45° FOV. Fundus photo. 2048 by 1536 pixels.
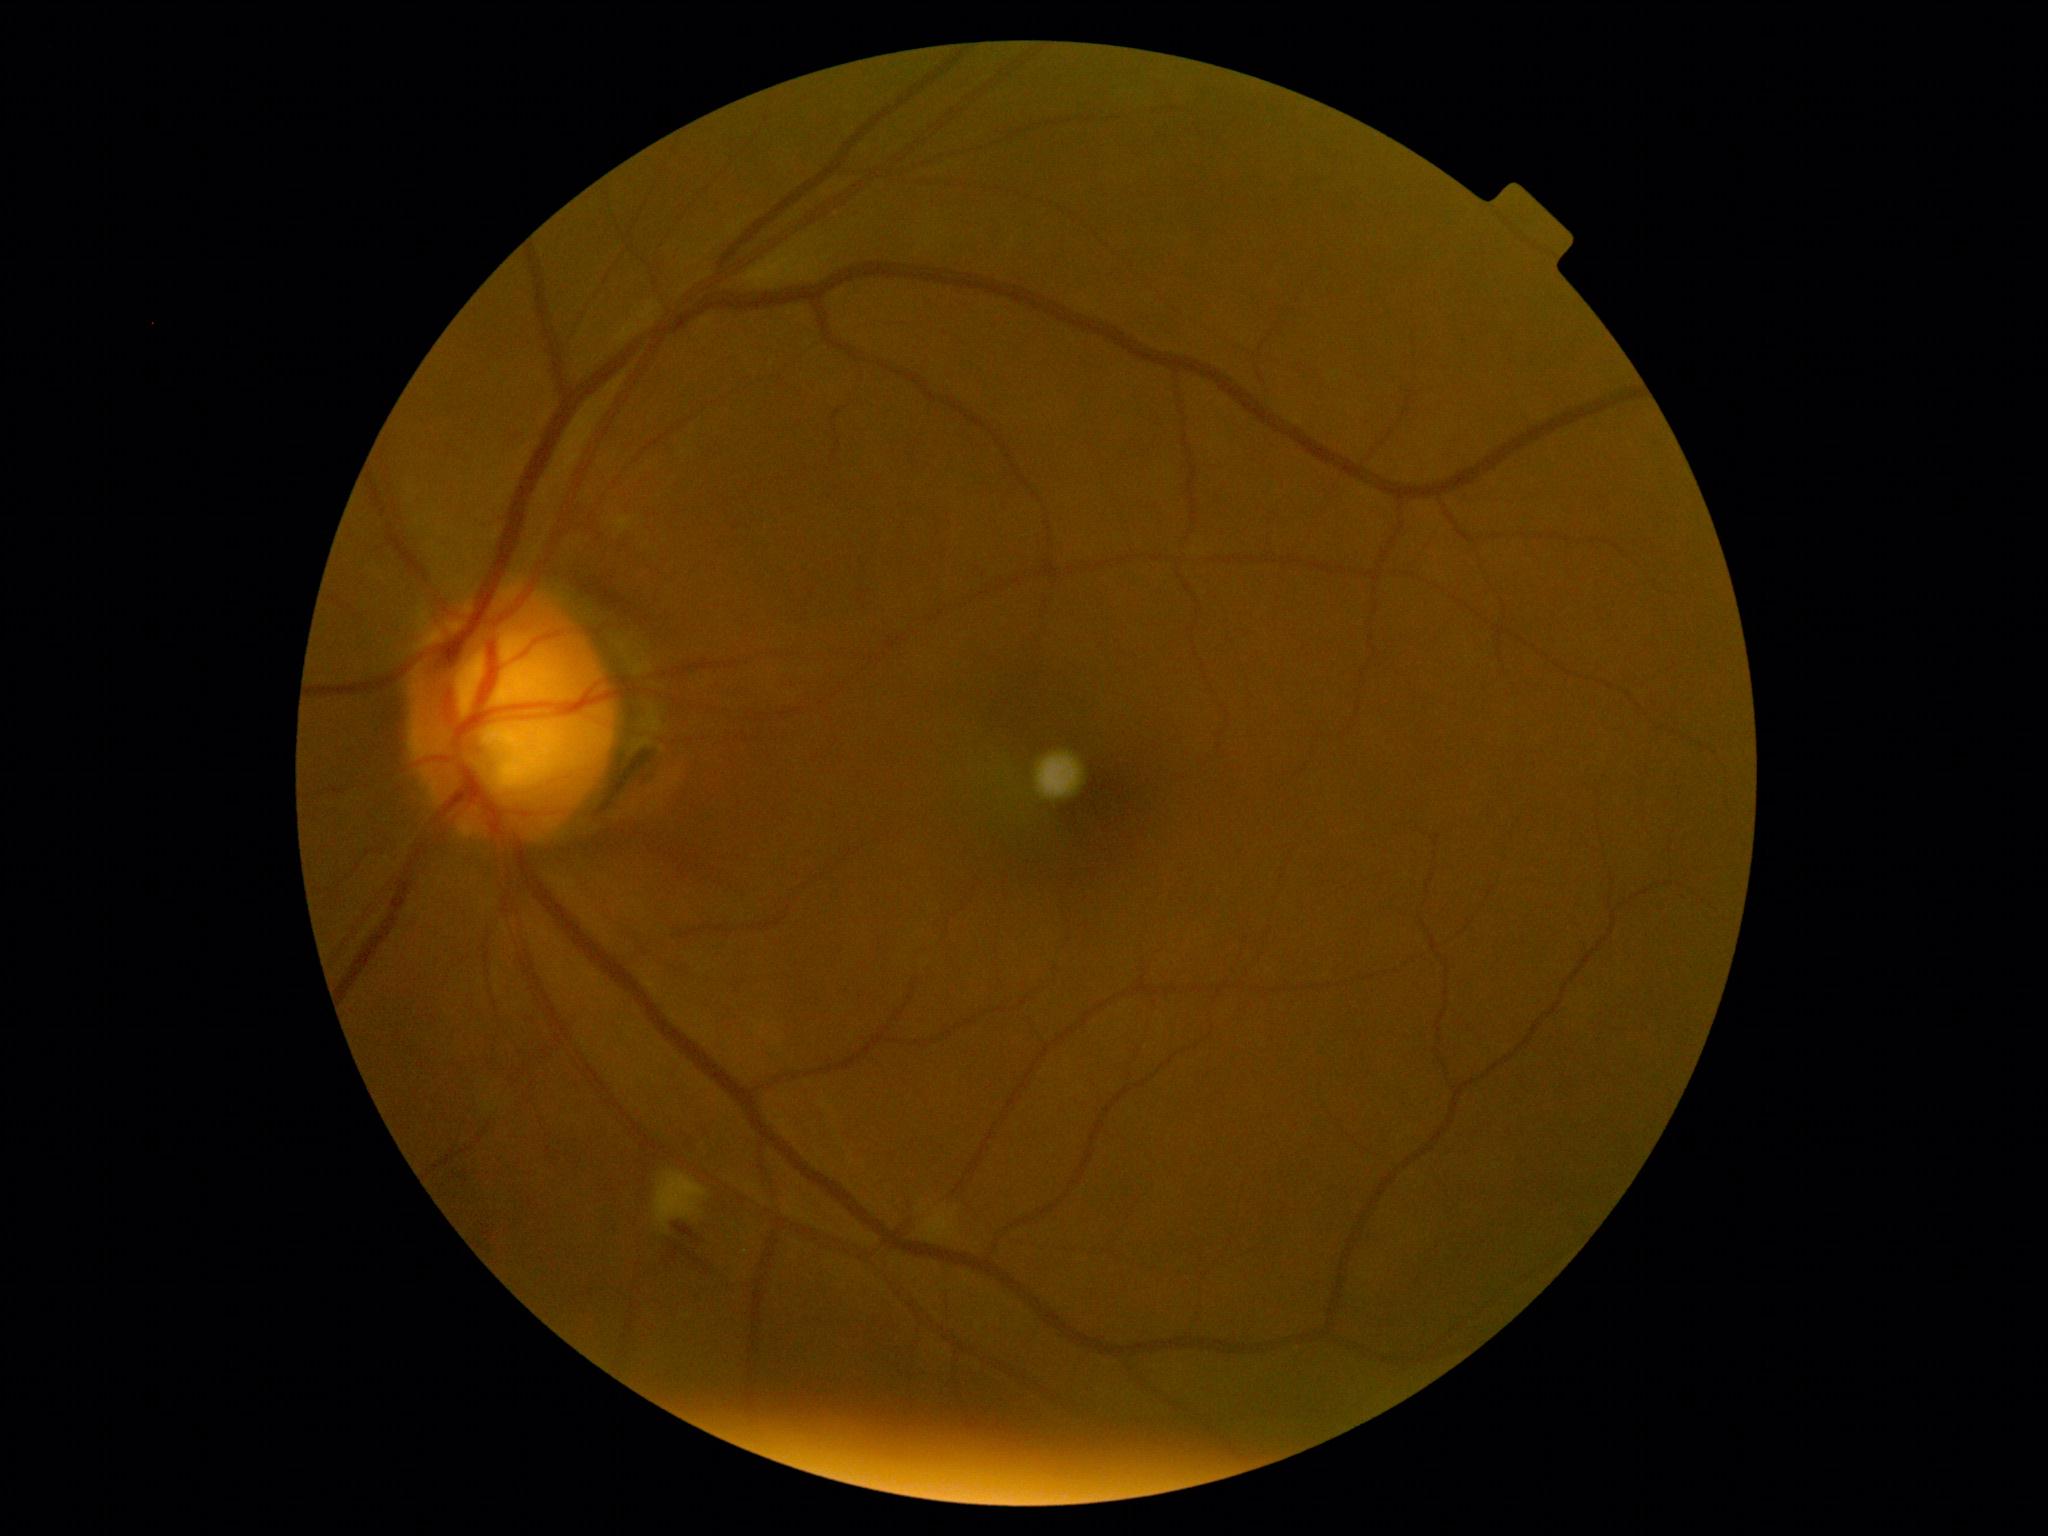

DR grade is 2 (moderate NPDR).